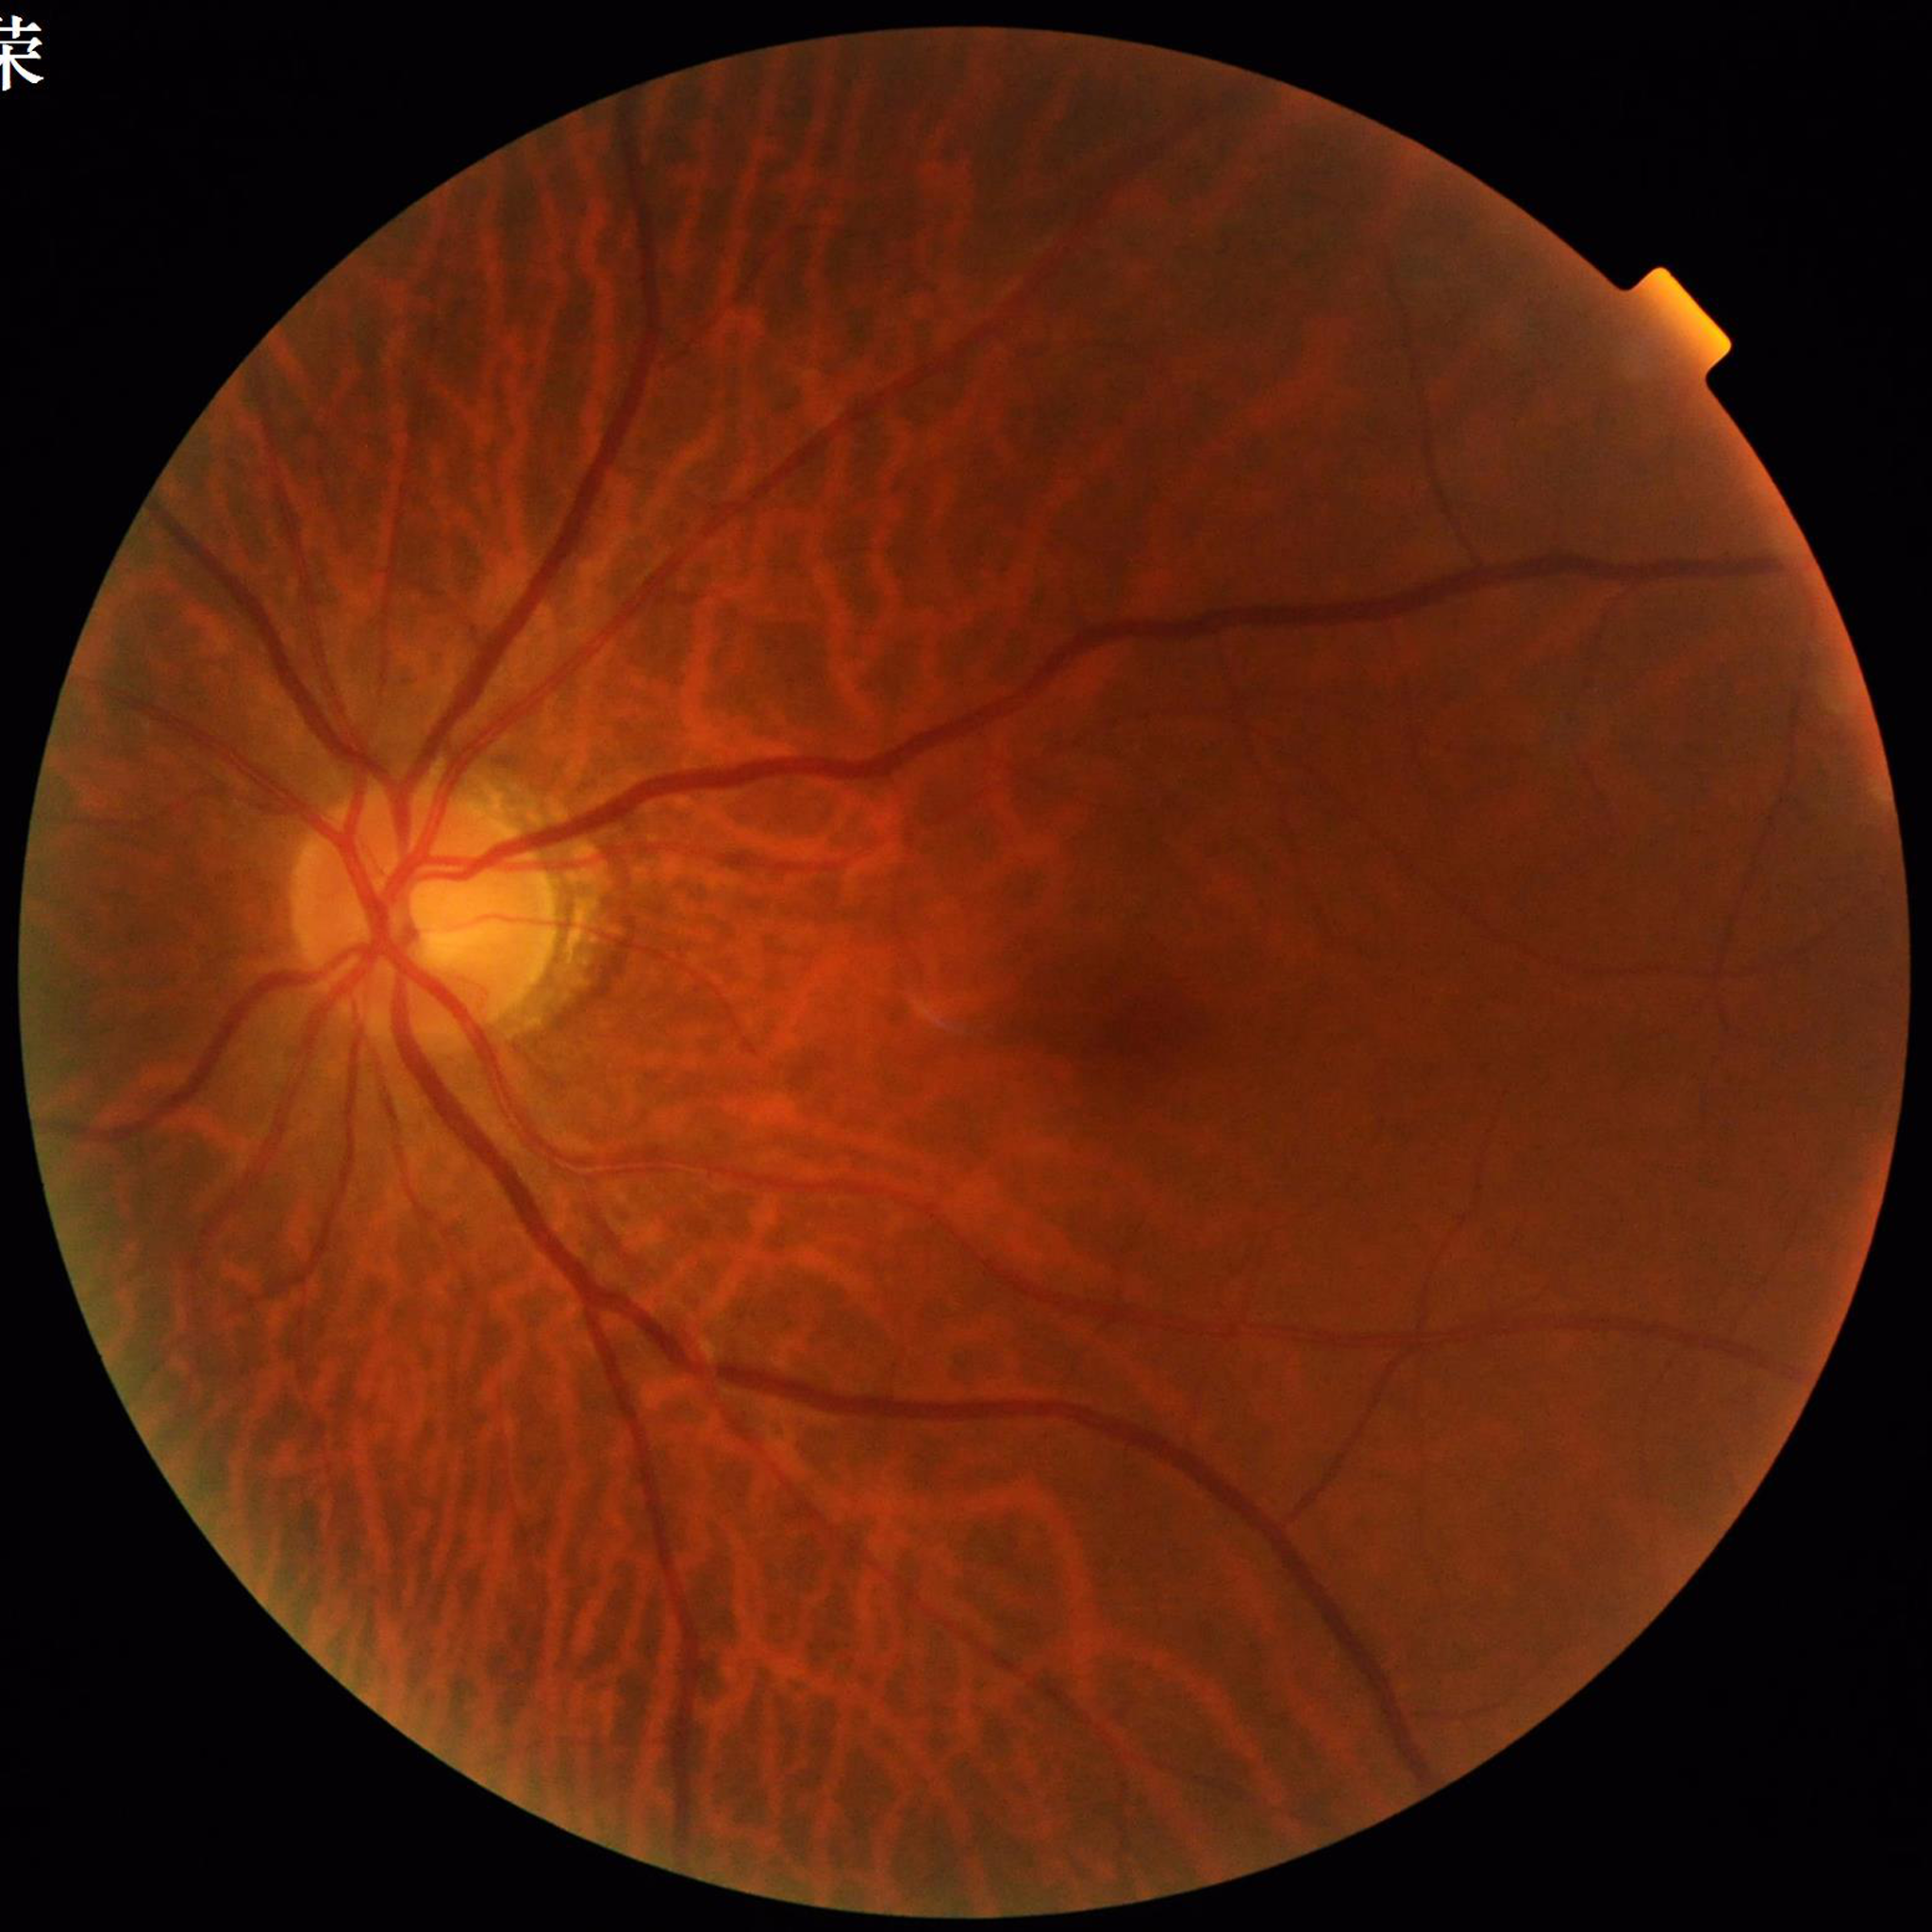 Fundus image of an eye with DR.